Wide-field fundus image from infant ROP screening; 640 x 480 pixels — 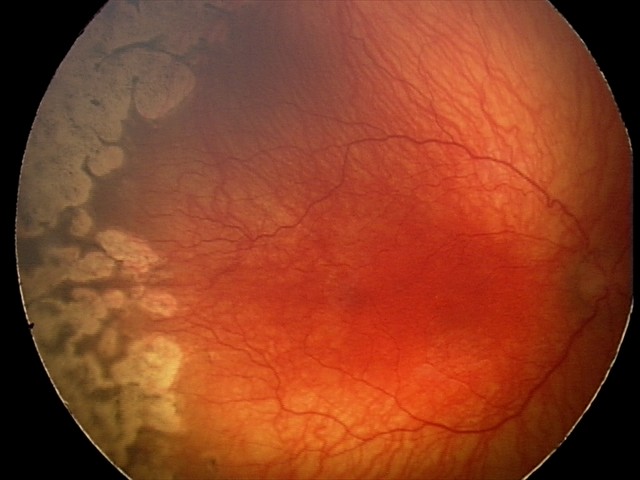
Plus disease present. Screening examination consistent with aggressive retinopathy of prematurity (A-ROP).